1380 by 1382 pixels; FOV: 45 degrees; color fundus photograph:
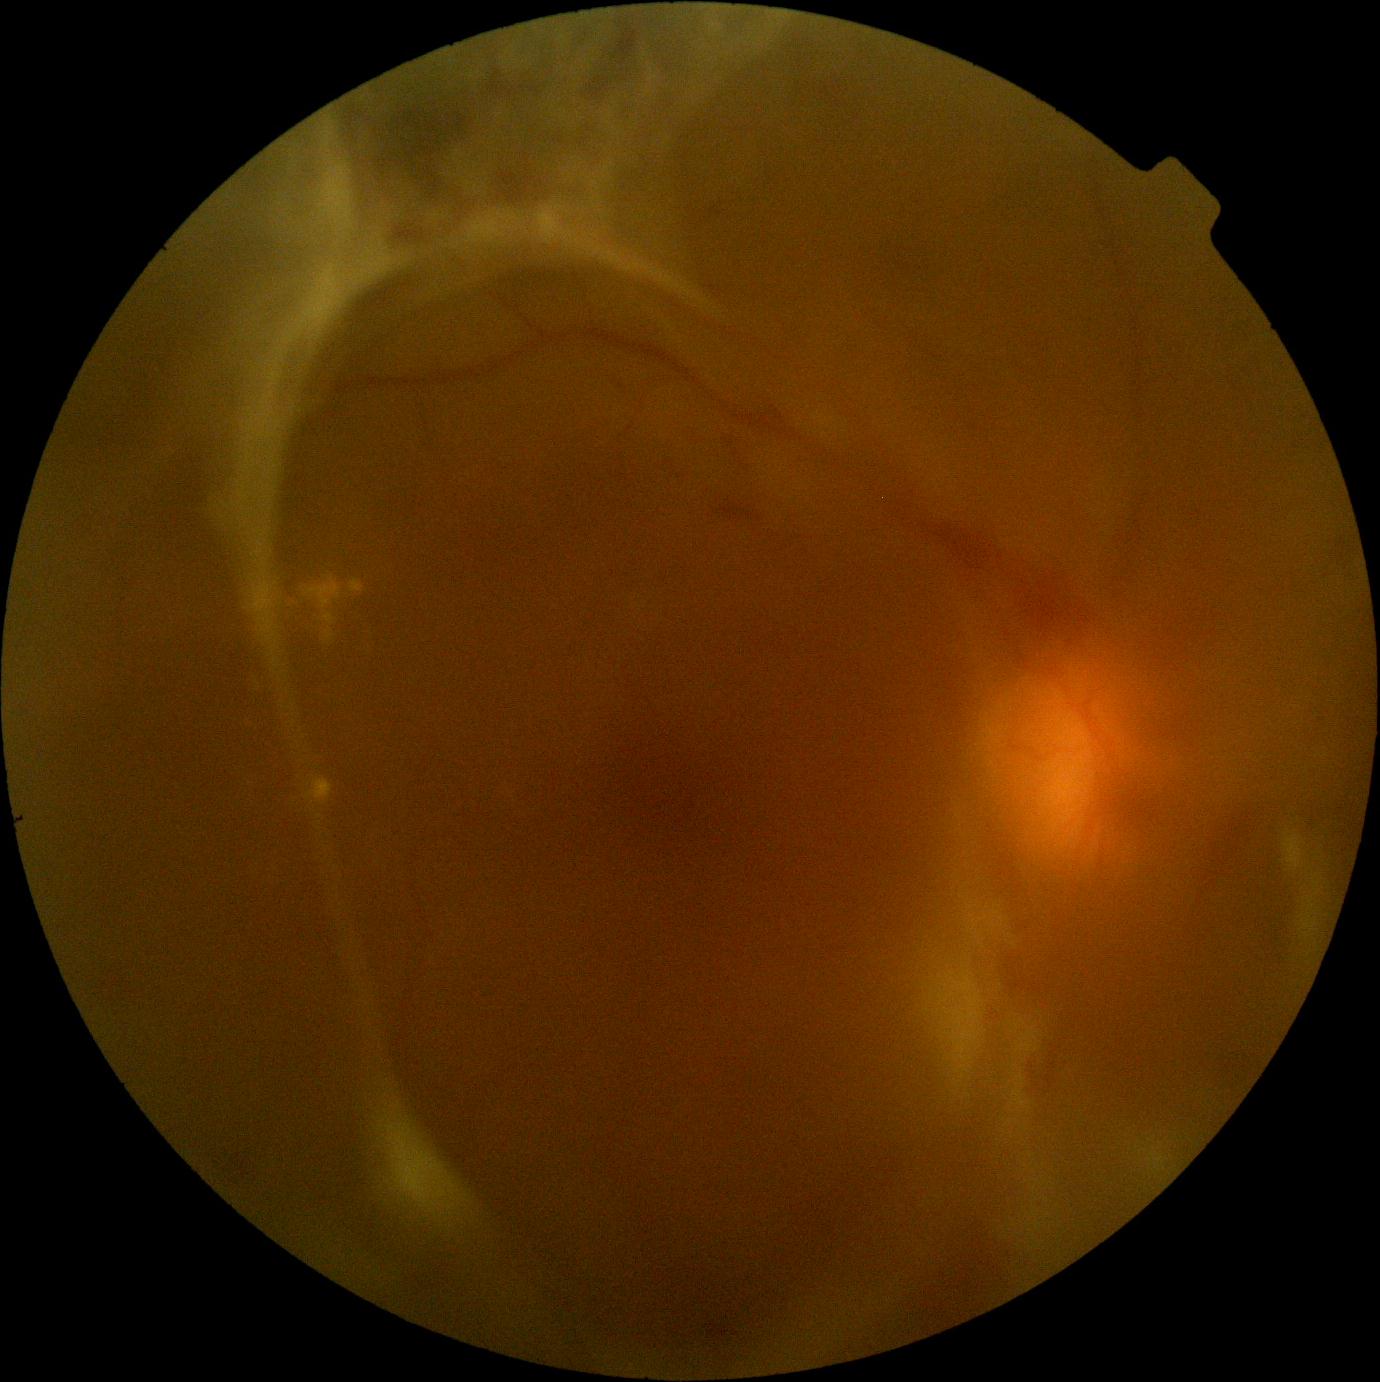 Retinopathy: grade 4.